Color fundus image · 45° field of view · 2352 x 1568 pixels.
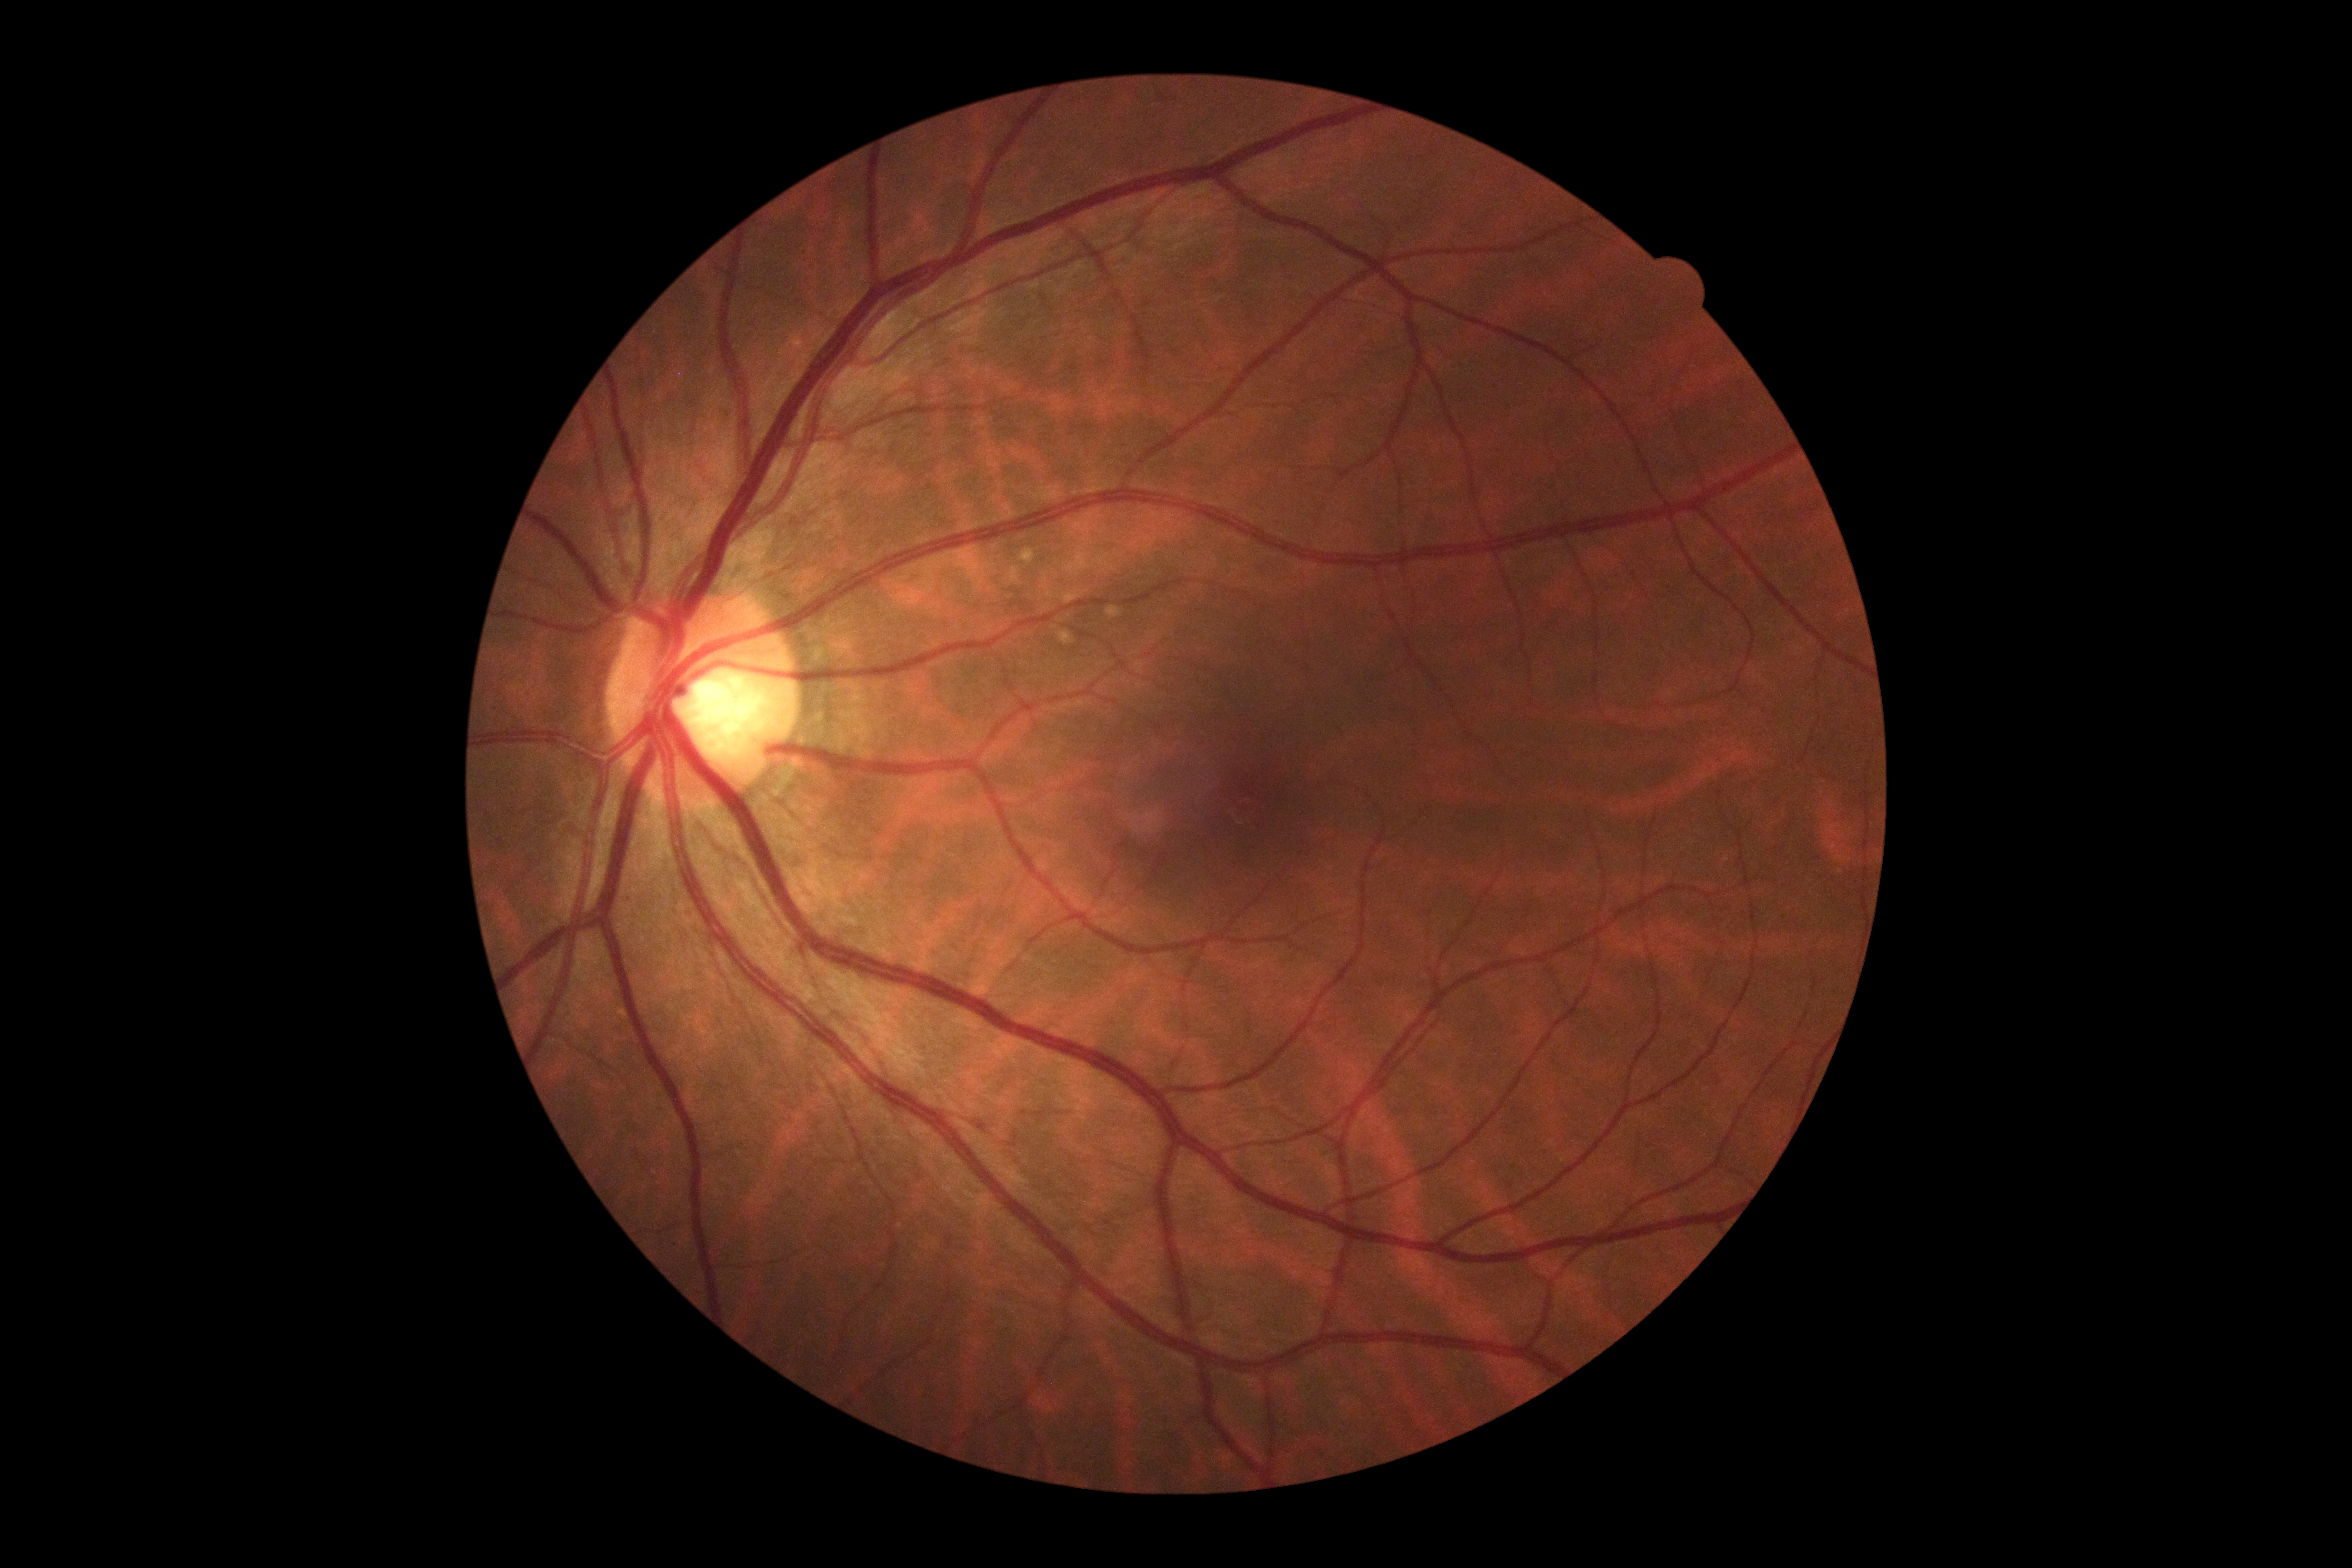 Findings:
– diabetic retinopathy (DR): grade 0 (no apparent retinopathy)
– DR impression: no apparent DR